Image size 2212x1659, retinal fundus photograph:
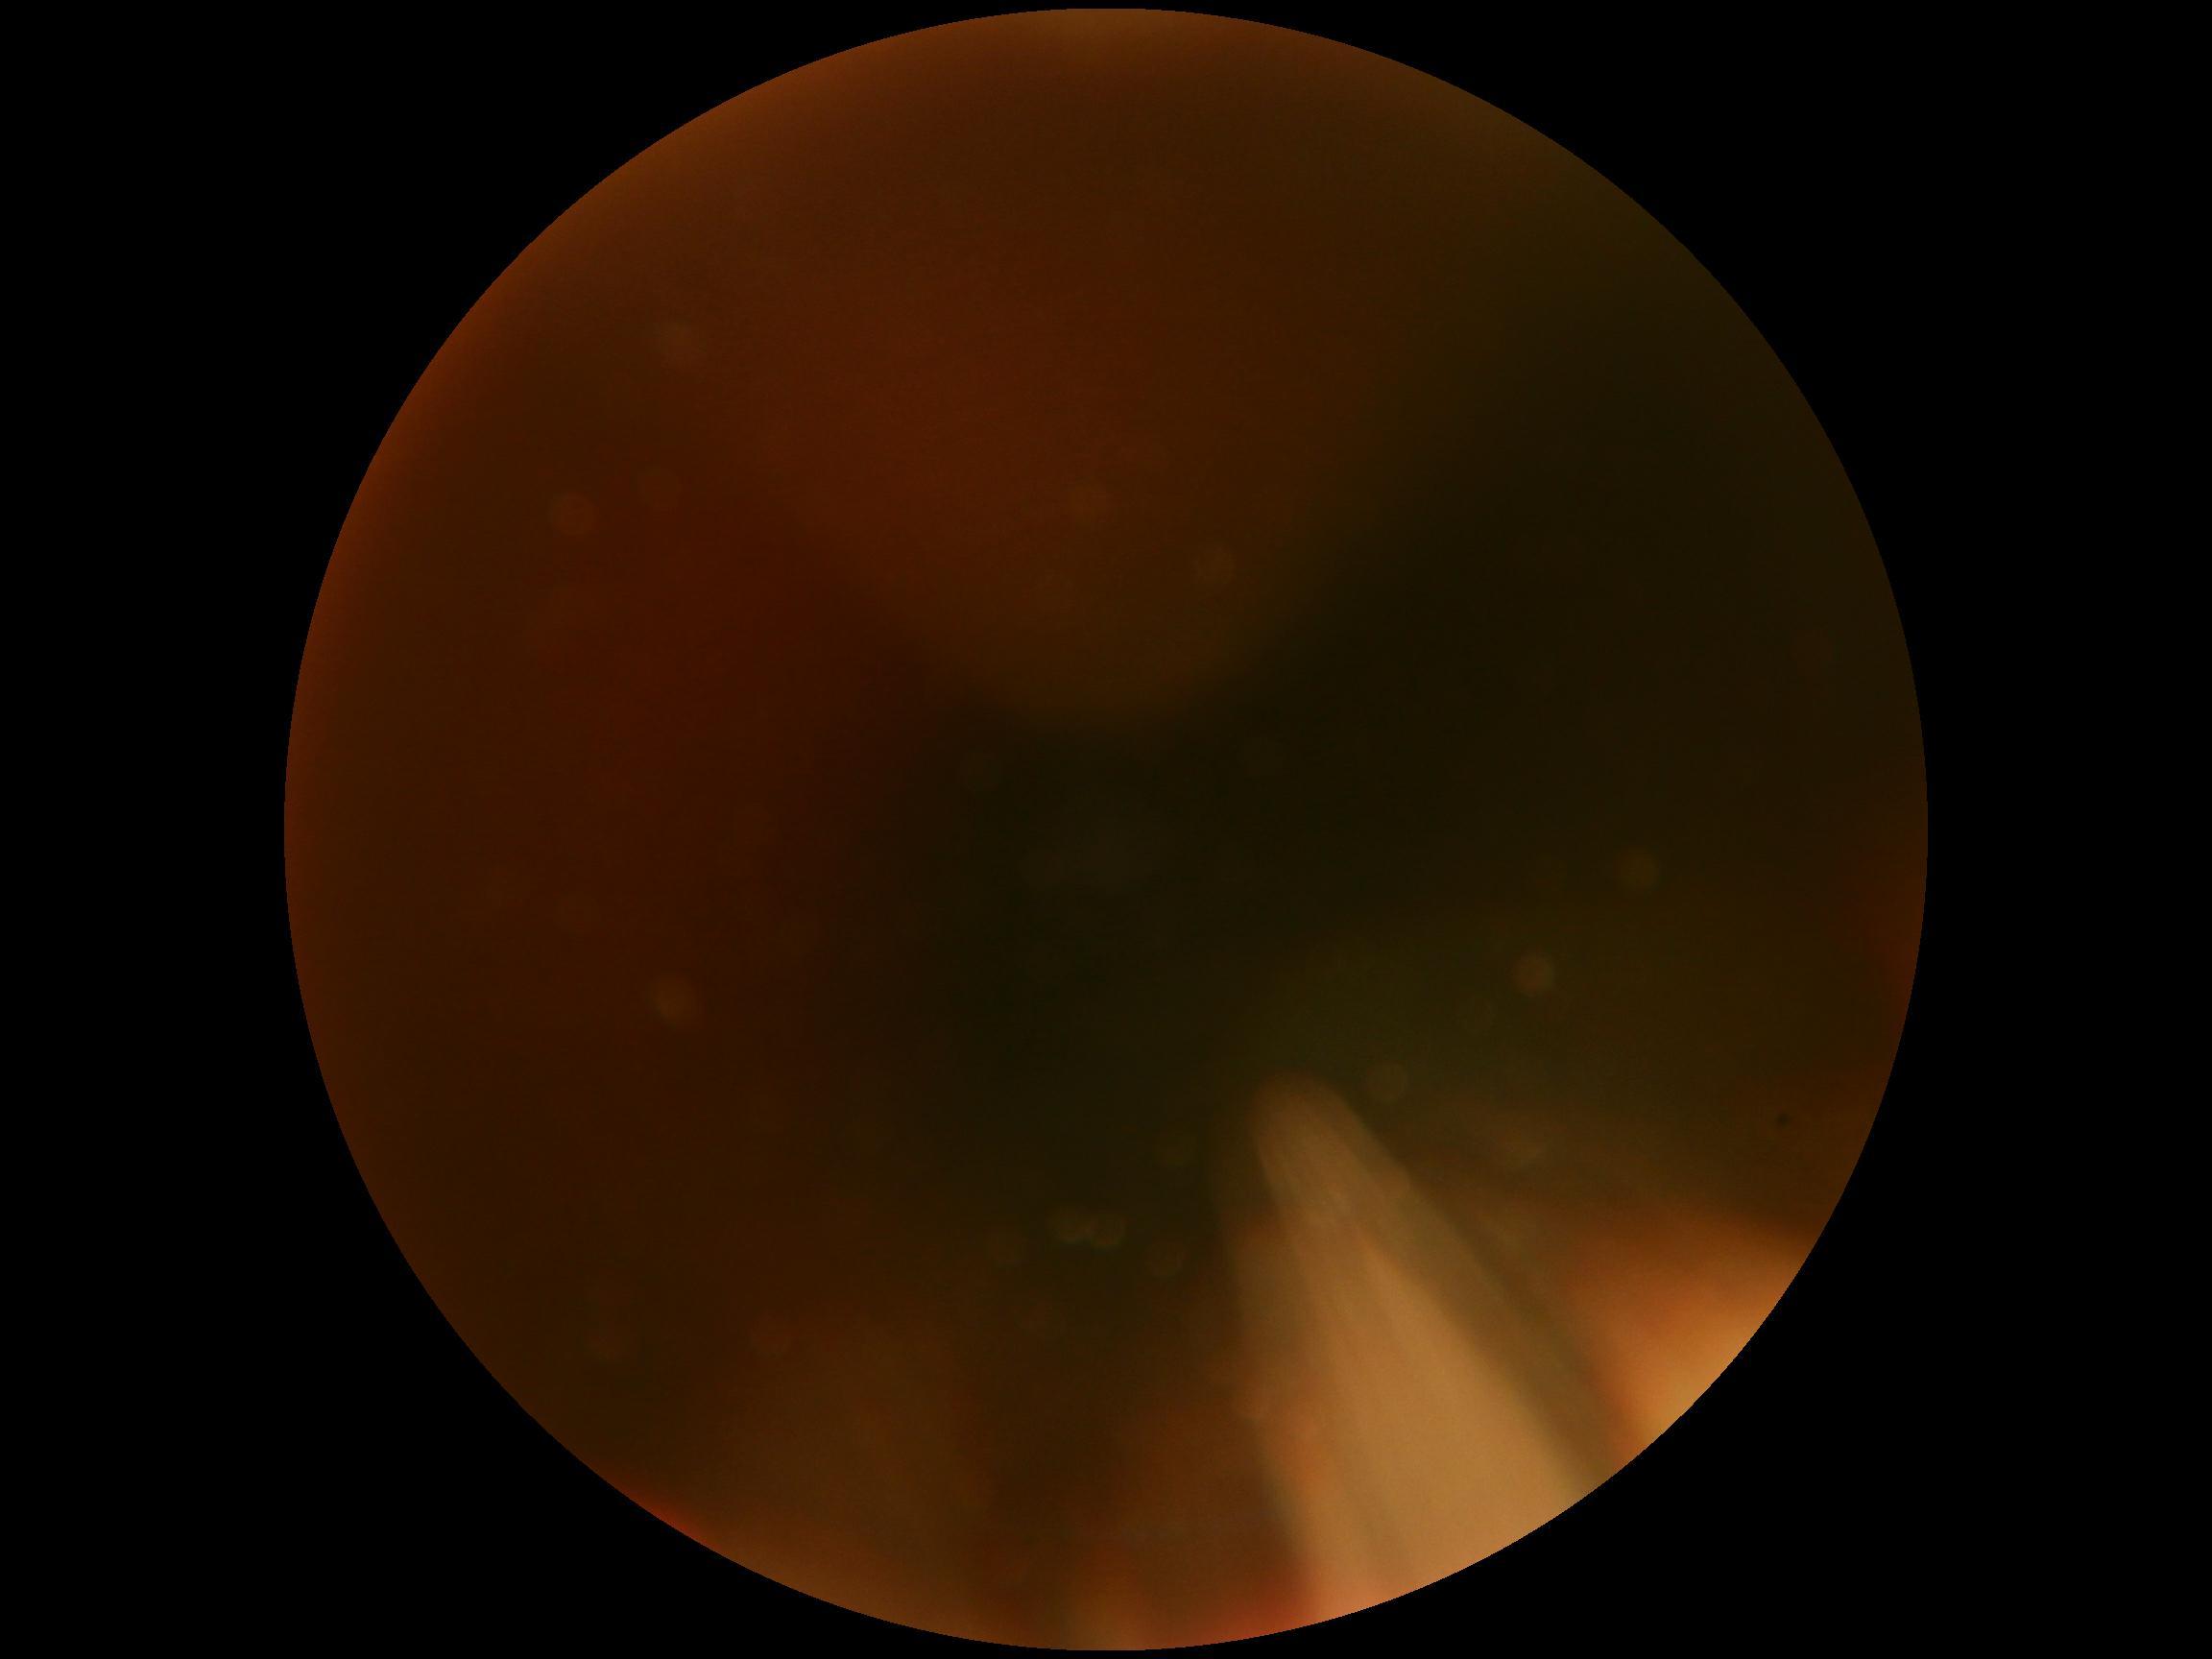

diabetic retinopathy (DR)=ungradable.